No pharmacologic dilation. Color fundus image: 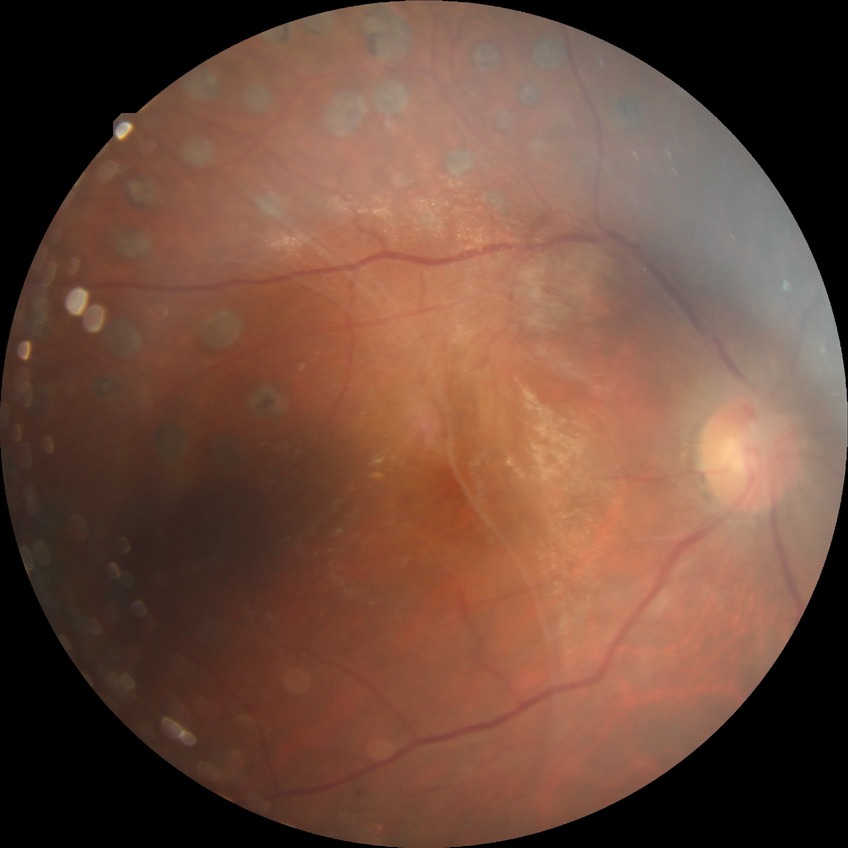

Diabetic retinopathy (DR): PDR (proliferative diabetic retinopathy).